Pediatric wide-field fundus photograph · 130° field of view (Clarity RetCam 3): 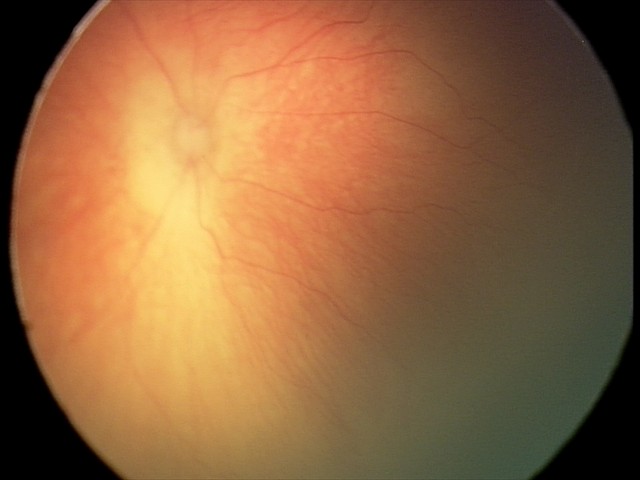 Q: What is the screening diagnosis?
A: retinopathy of prematurity (ROP) stage 0 — incomplete retinal vascularization without a demarcation line